Modified Davis classification; without pupil dilation; 848x848px; color fundus image; NIDEK AFC-230 fundus camera:
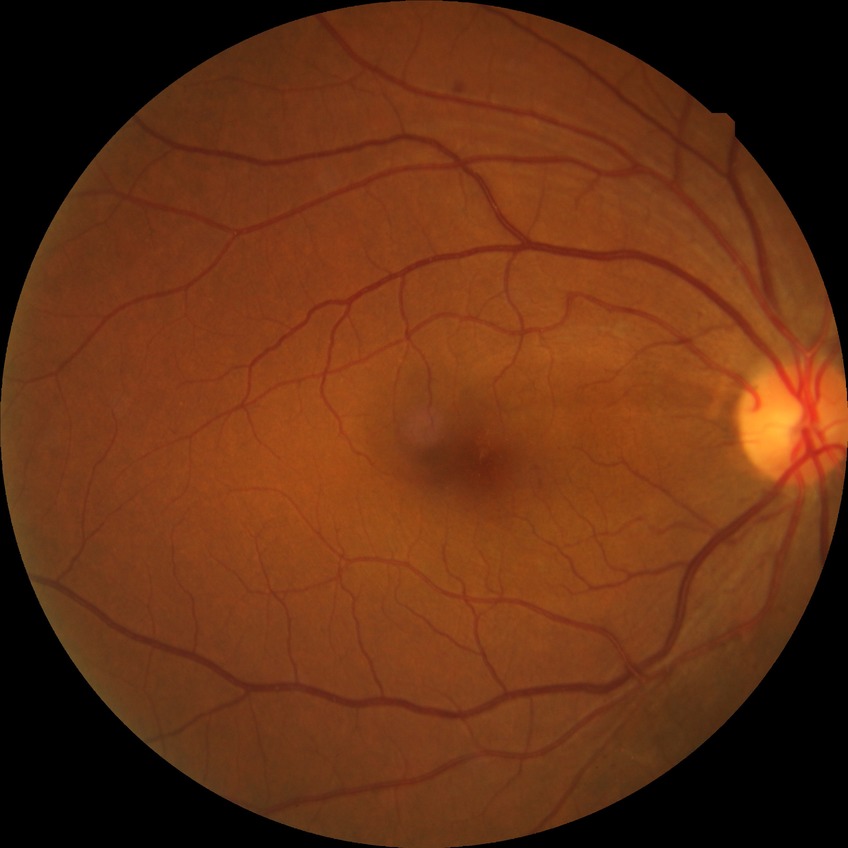

Disease class: non-proliferative diabetic retinopathy.
Davis grading is simple diabetic retinopathy.